DR severity per modified Davis staging — 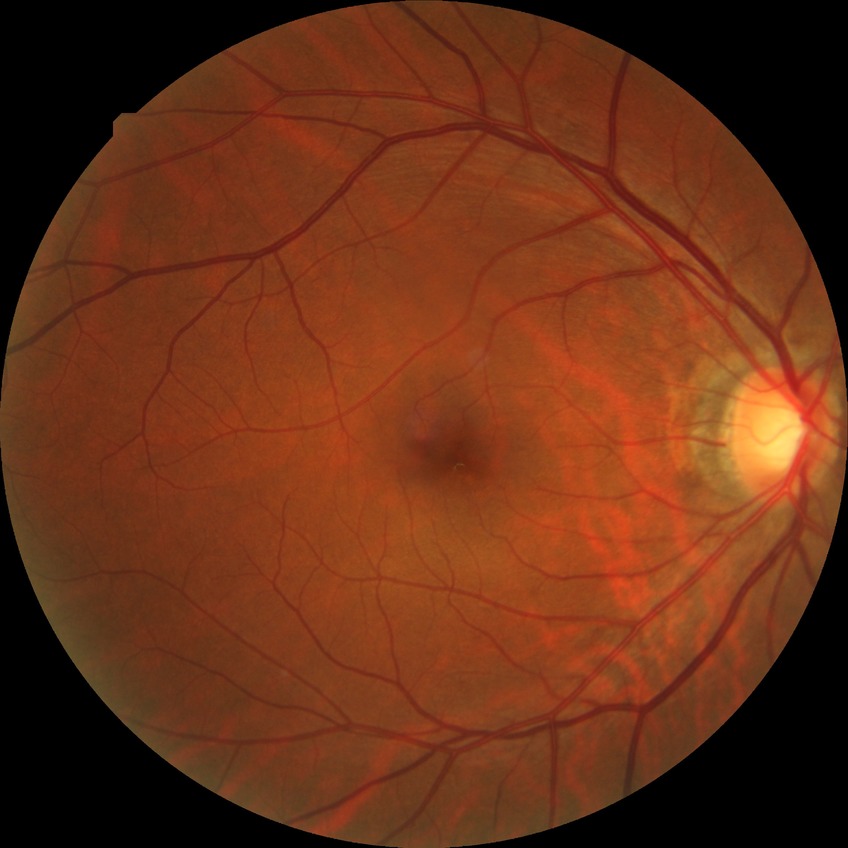
diabetic retinopathy (DR)=simple diabetic retinopathy (SDR).